Nonmydriatic fundus photograph, color fundus image — 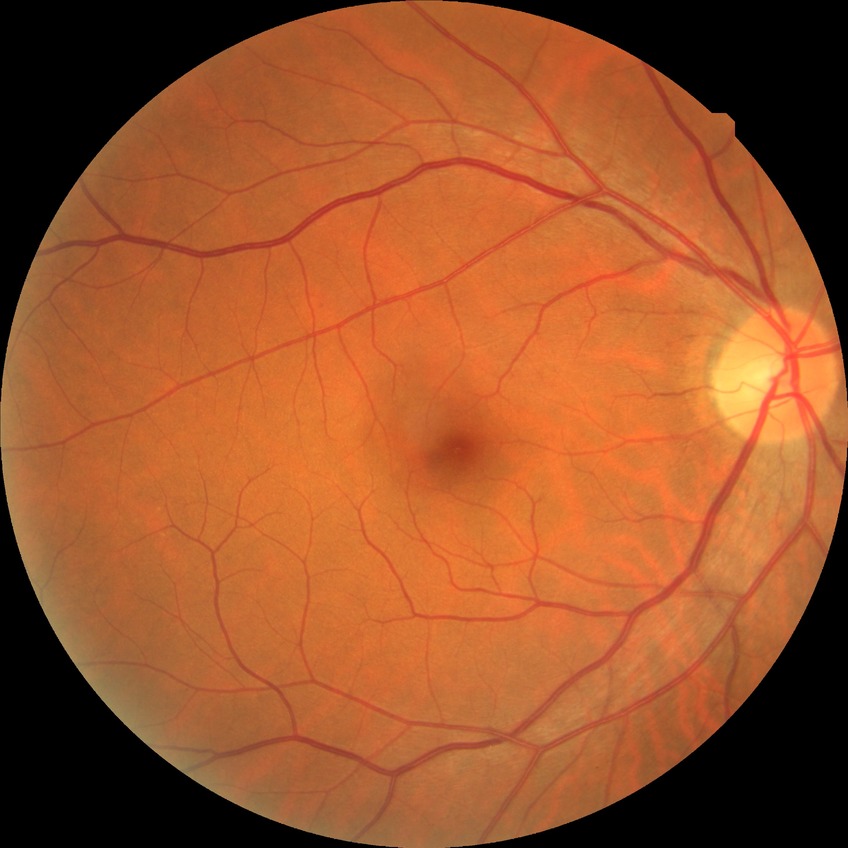

Assessment:
• retinopathy grade — no diabetic retinopathy